1240 by 1240 pixels. Infant wide-field retinal image: 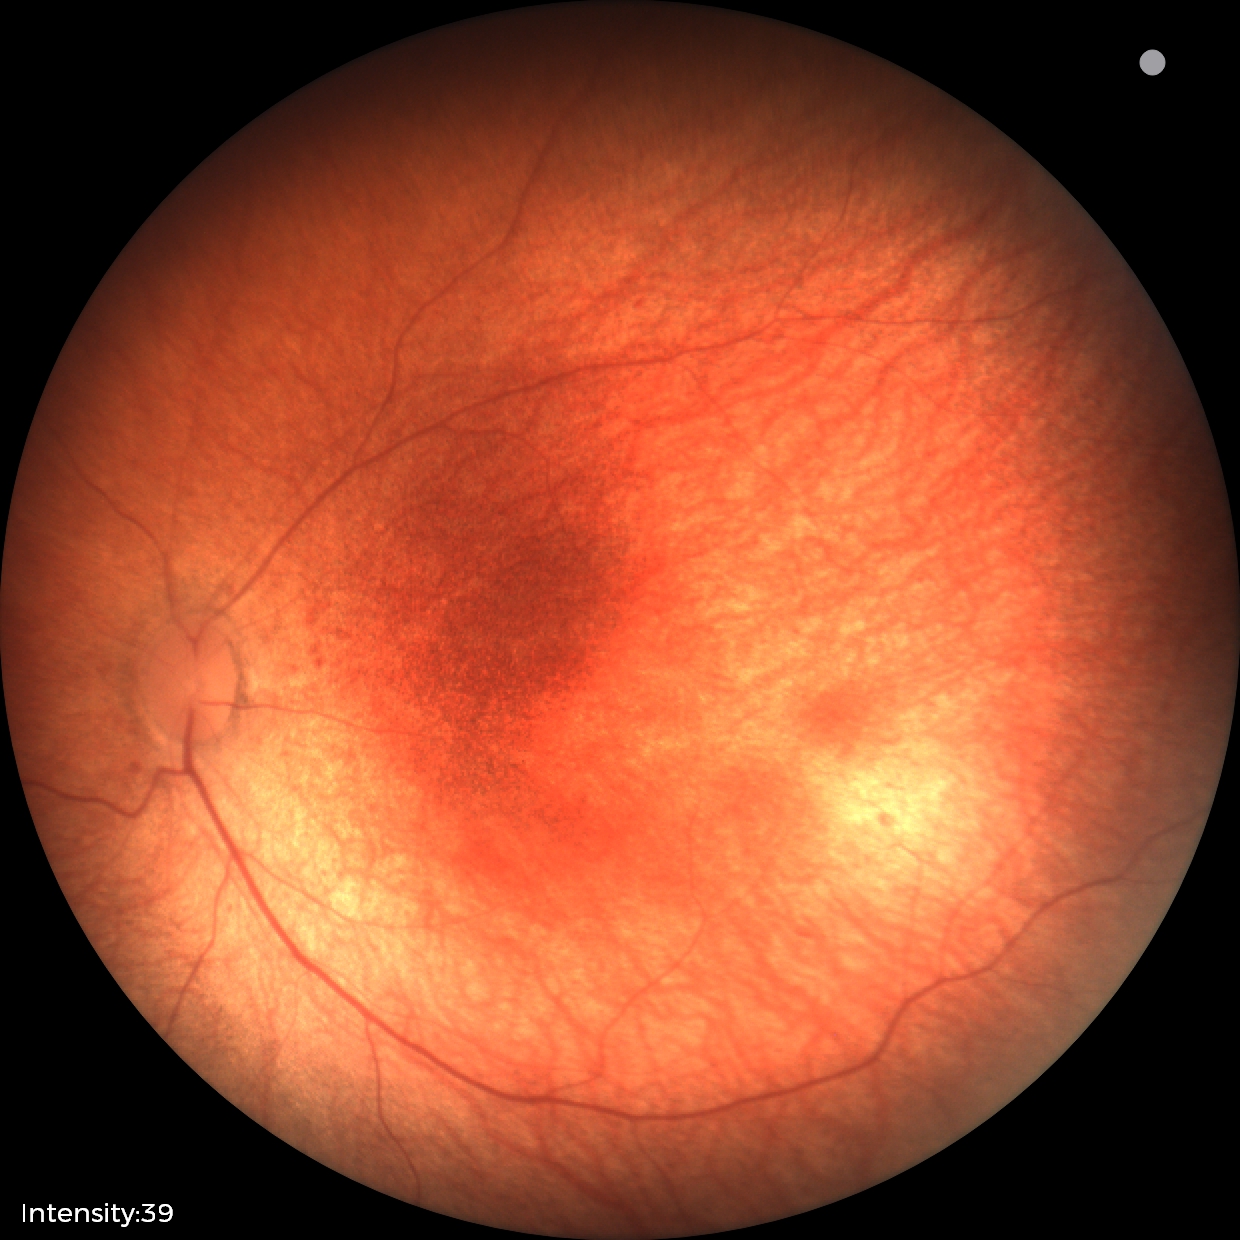
Screening: normal fundus examination.